Color fundus photograph: 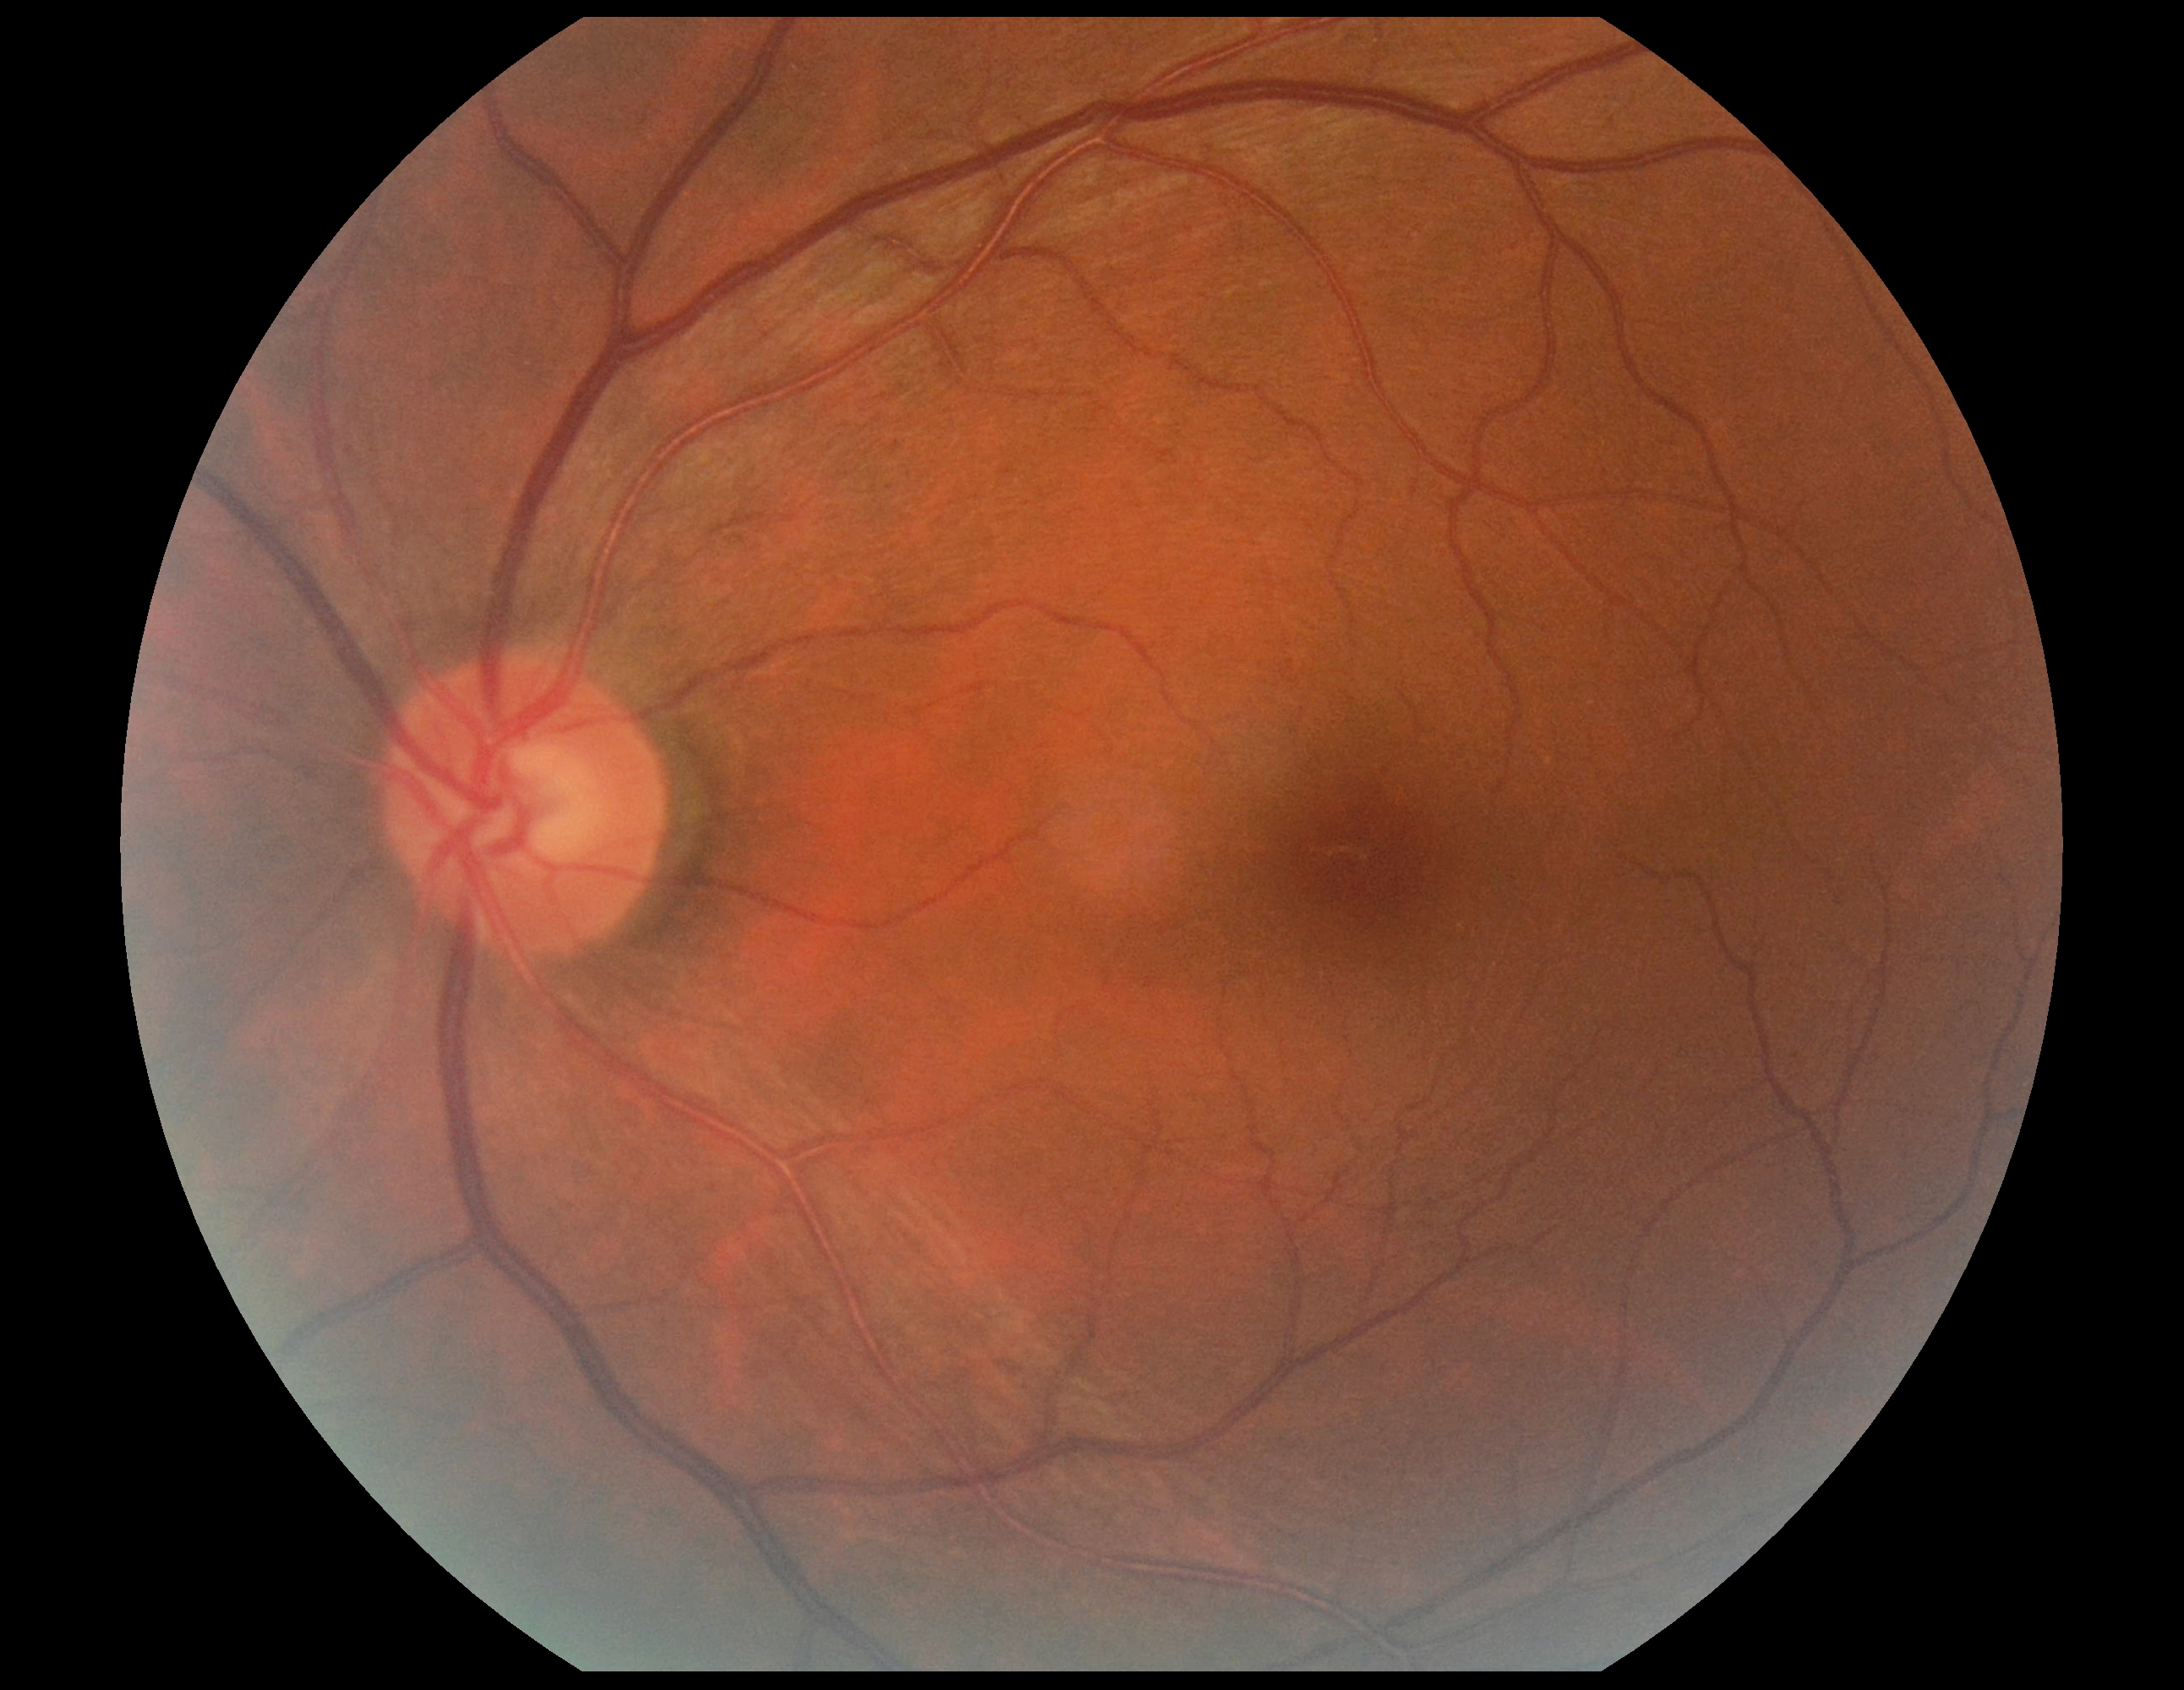

DR: 0.